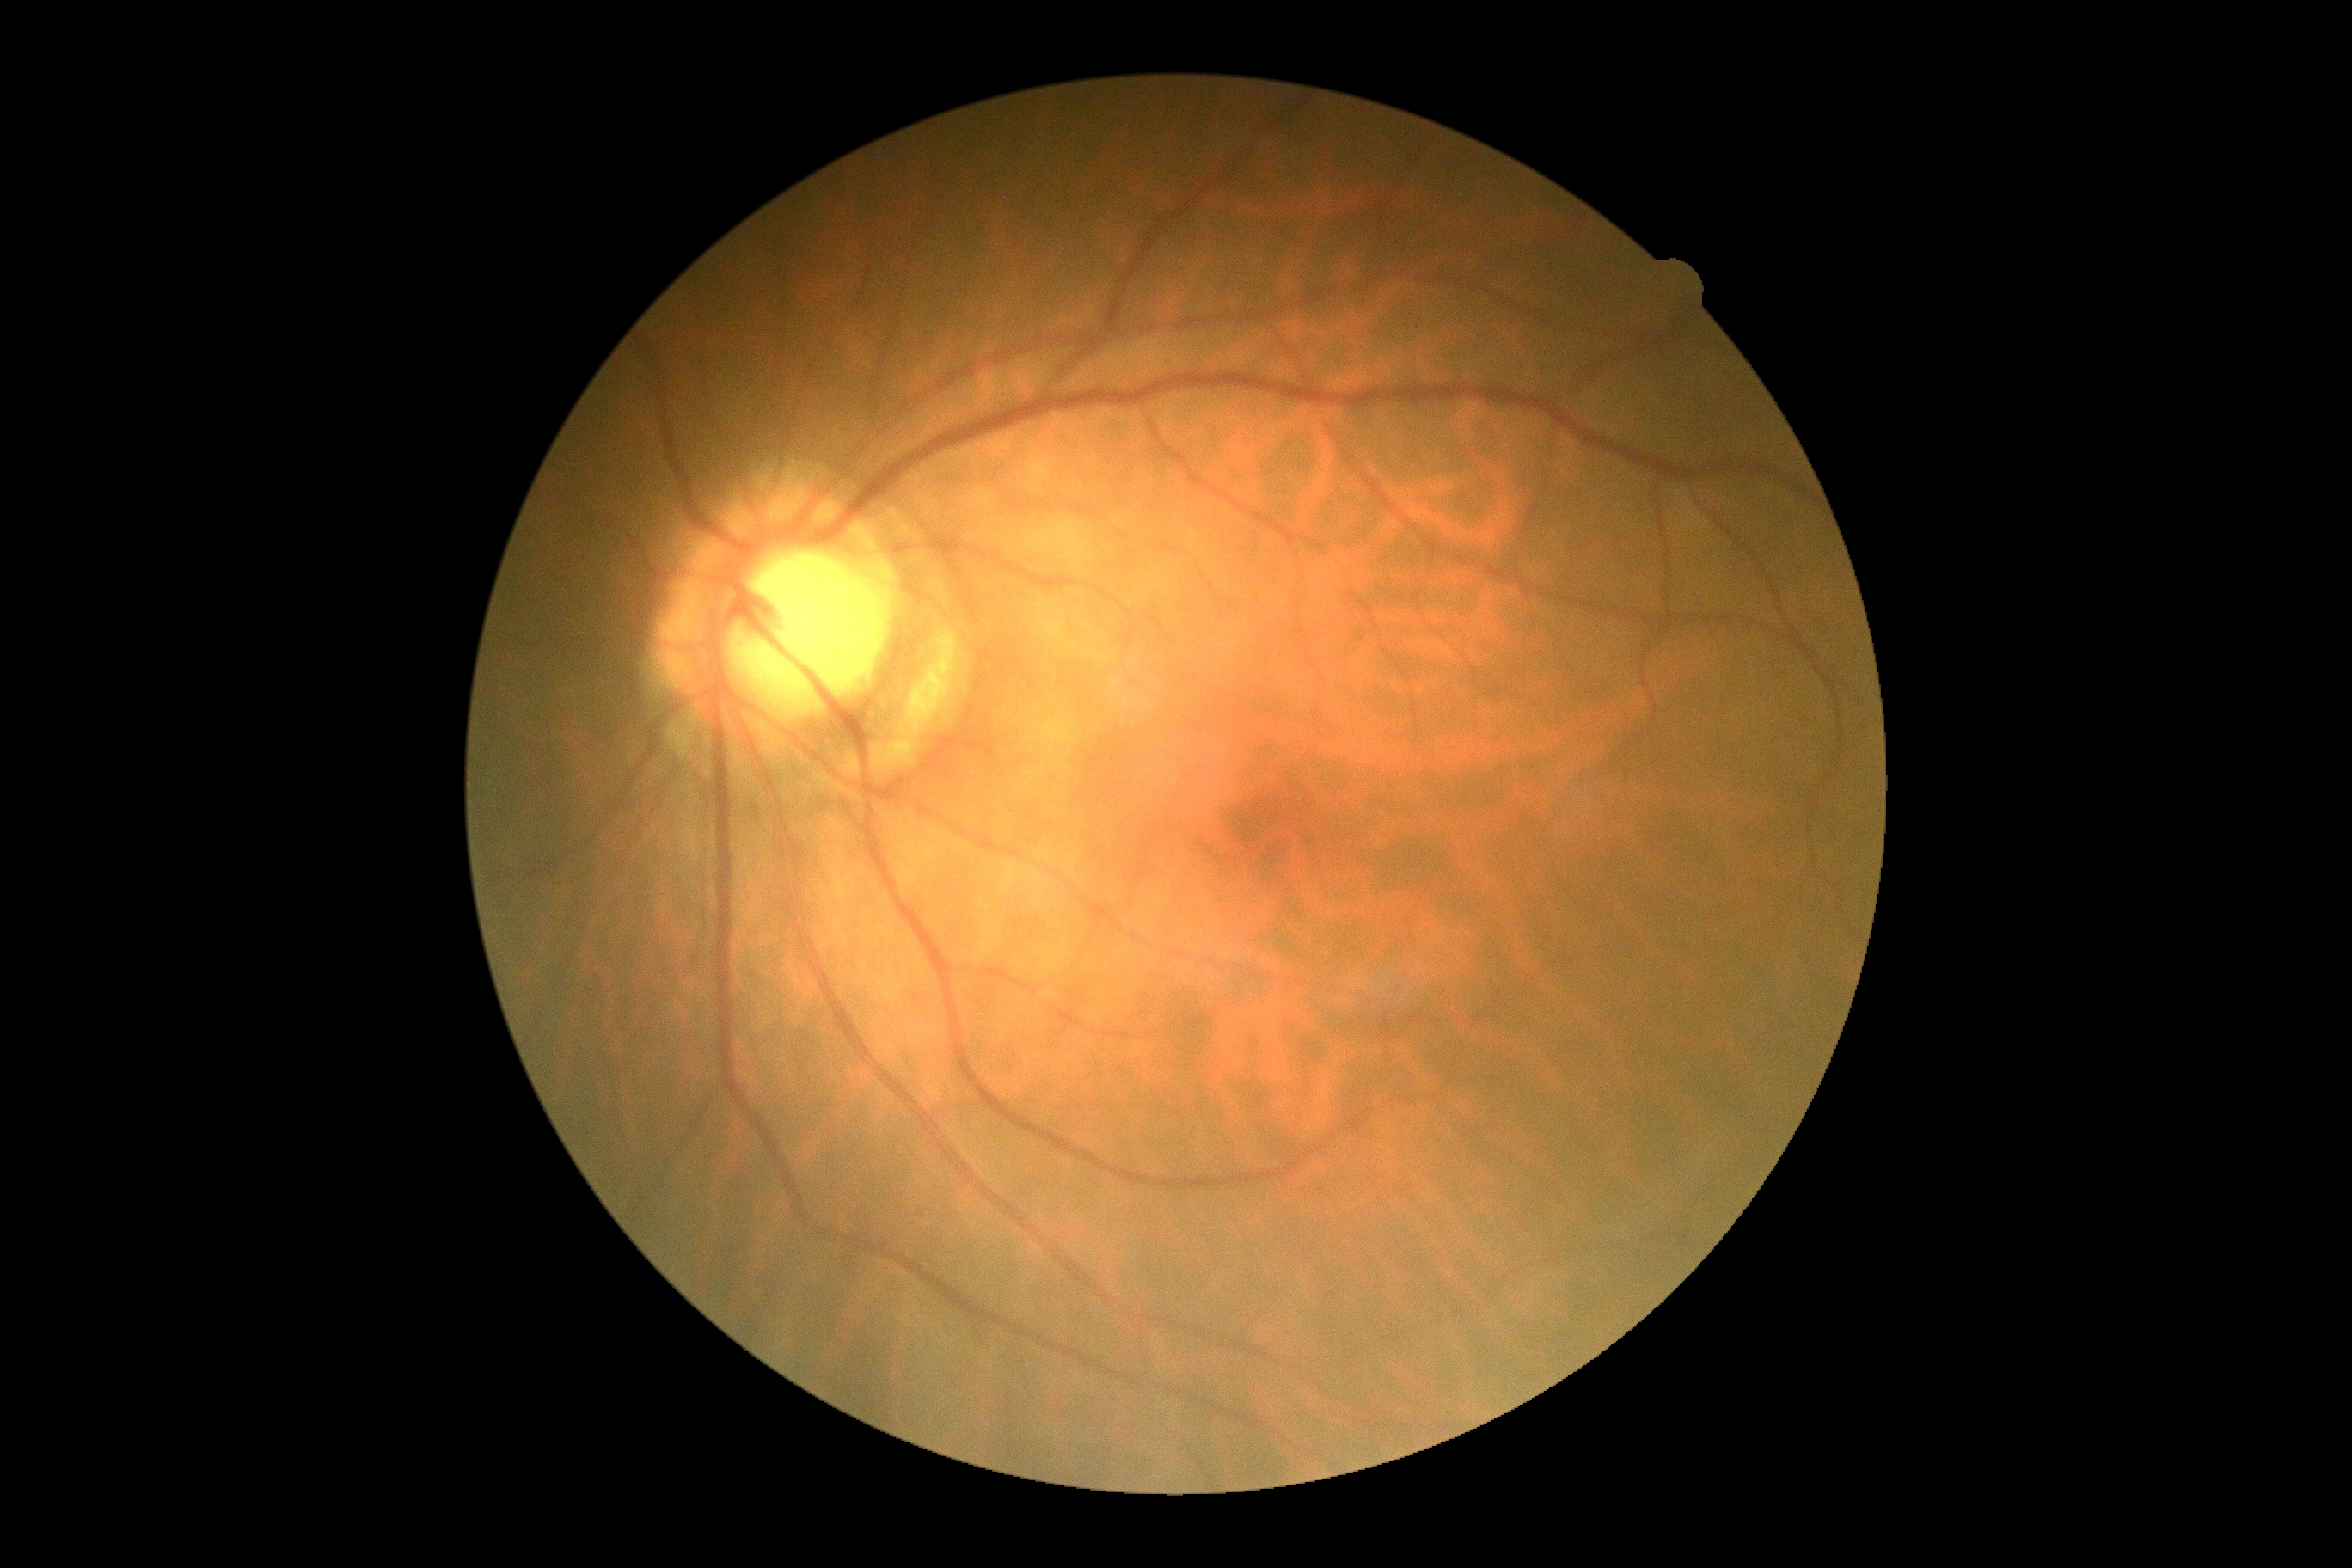

• diabetic retinopathy — 0/4
• DR impression — no apparent DR